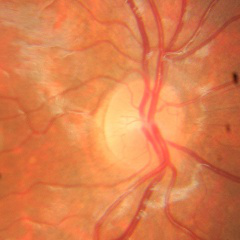

Glaucoma diagnosis: no glaucomatous changes.